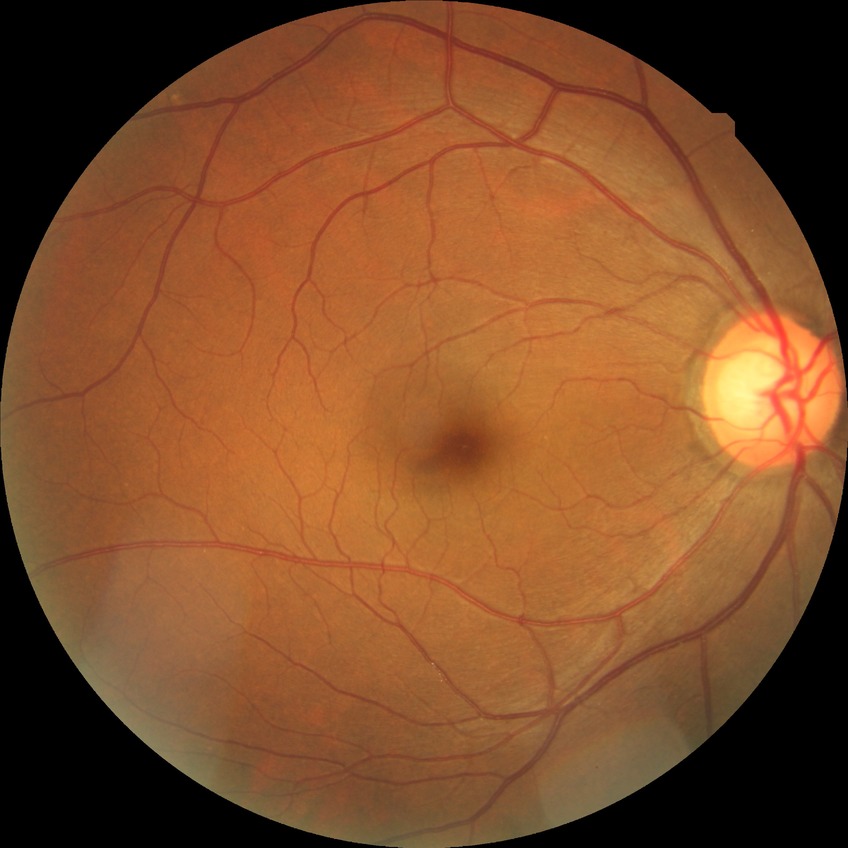

DR severity: NDR. No signs of diabetic retinopathy.